1659x2212px. Camera: Remidio smartphone fundus camera. Color fundus photograph: 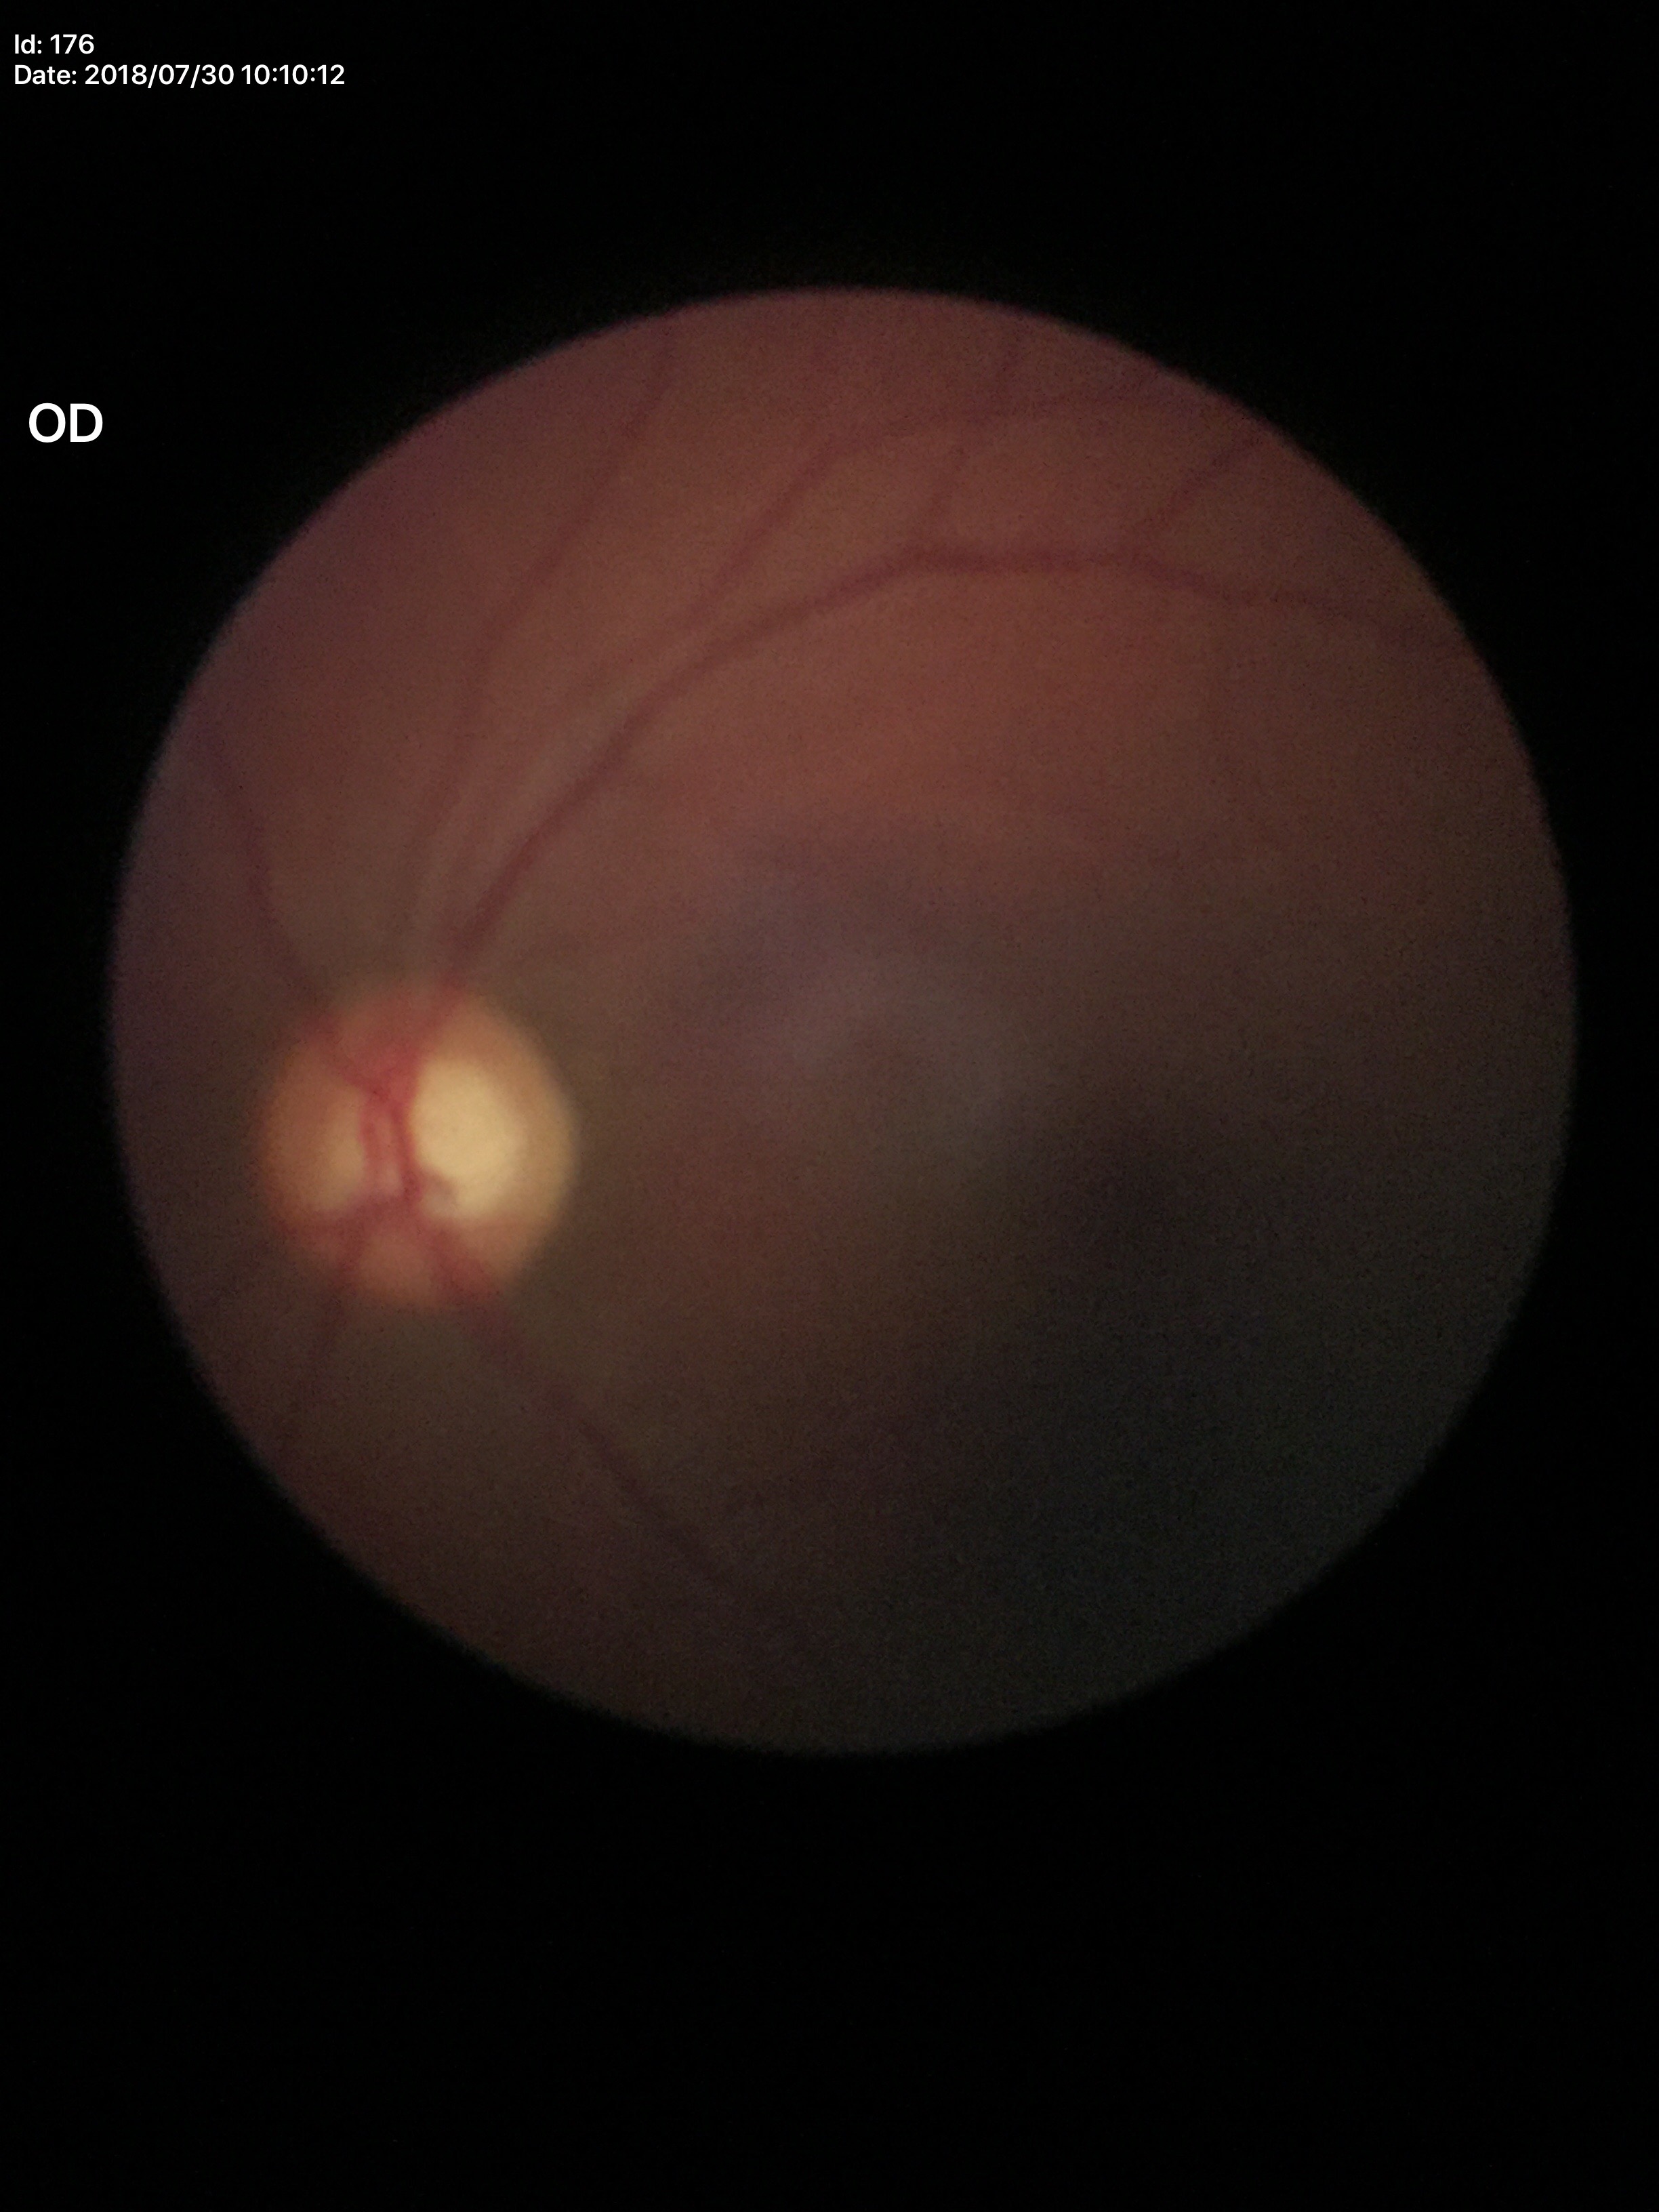
Vertical CDR is 0.57. Area C/D ratio: 0.39. Glaucoma screening: not suspect.